Acquired with a NIDEK AFC-230. 848x848. Fundus photo
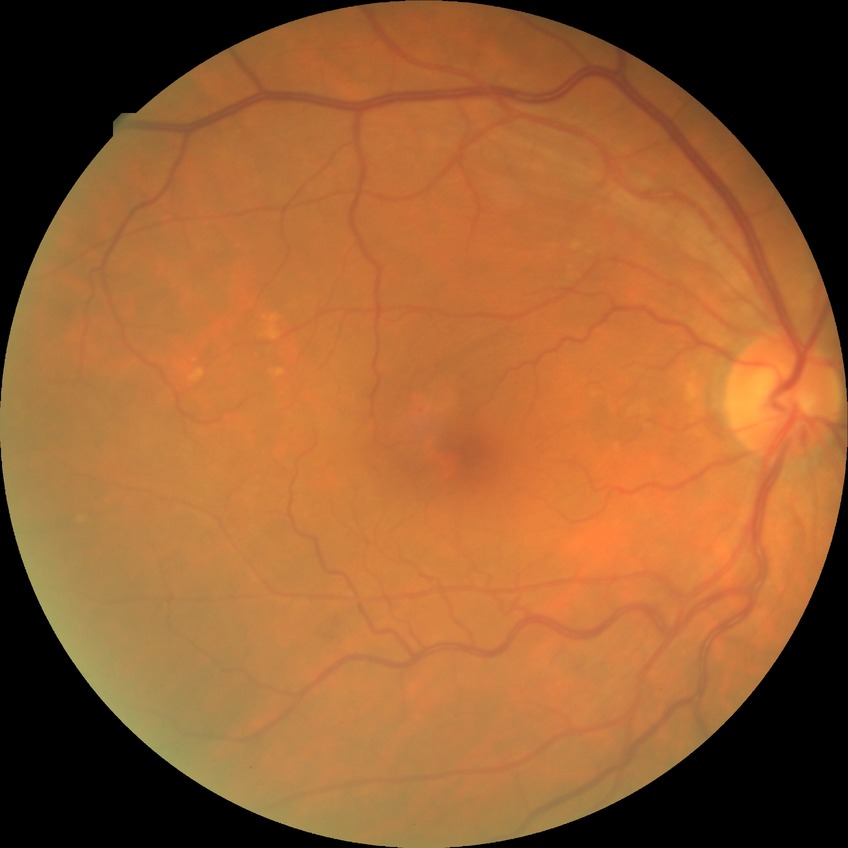 Retinopathy stage is proliferative diabetic retinopathy.